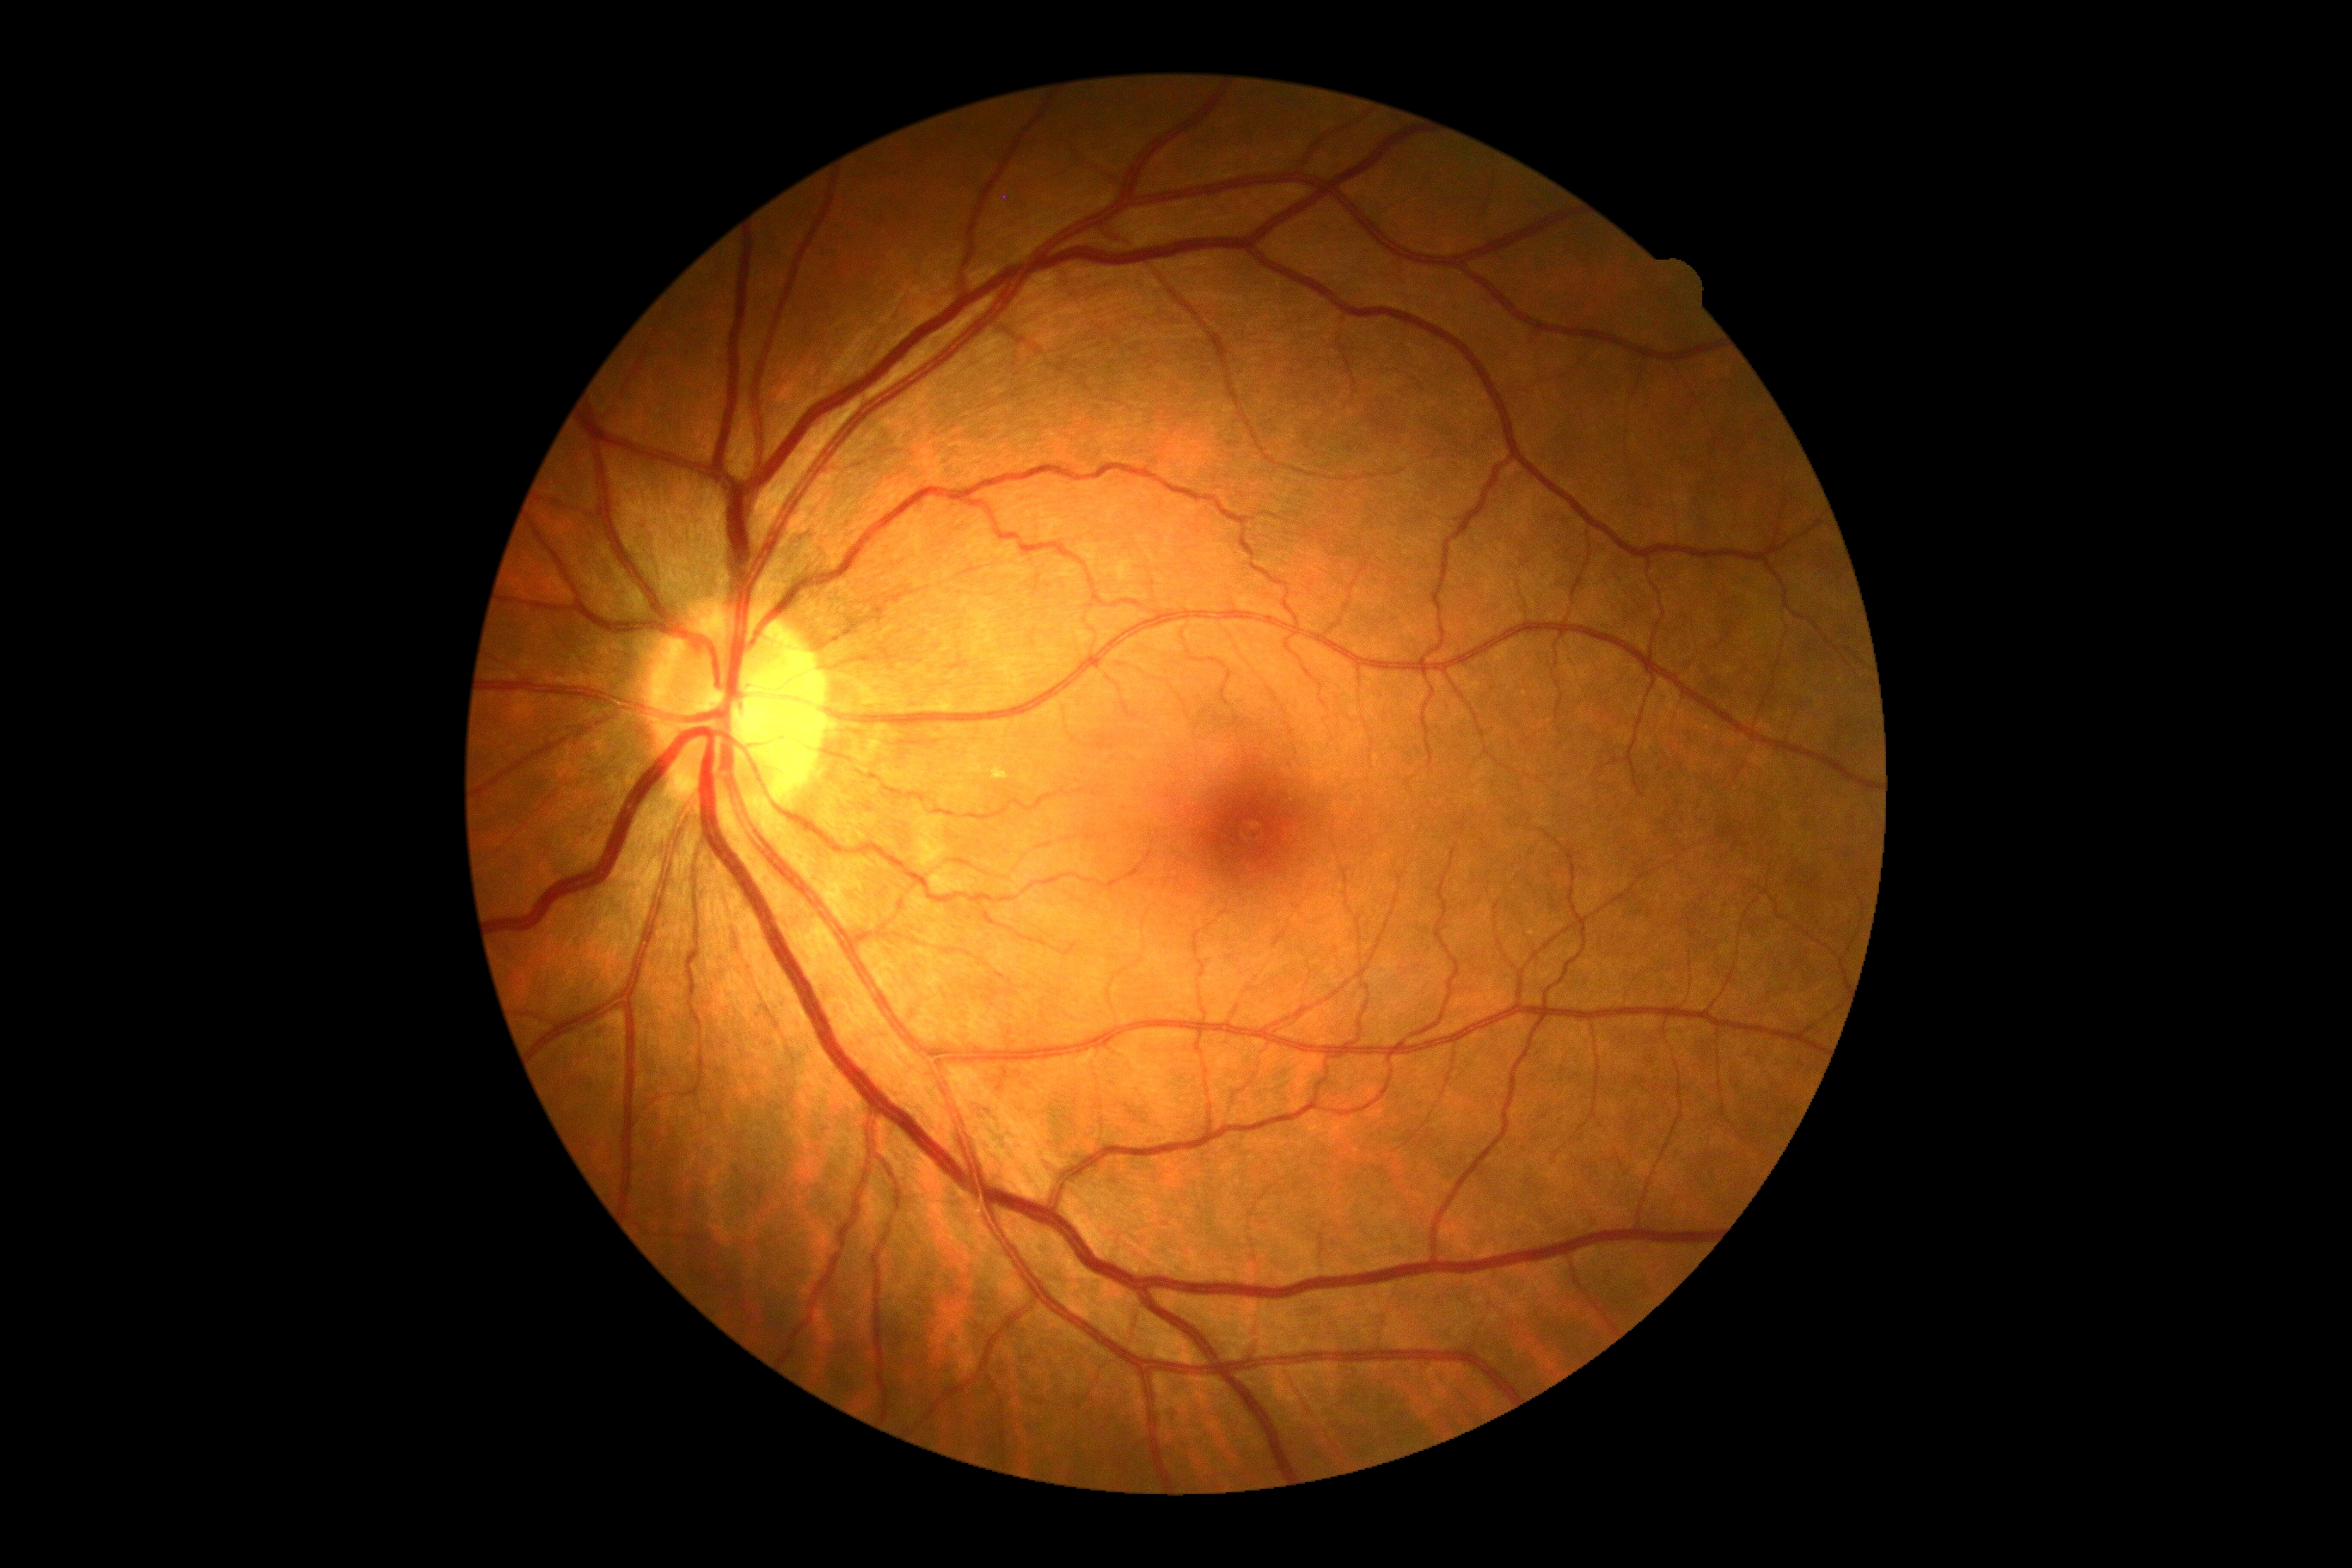
DR severity is 0 — no visible signs of diabetic retinopathy.